848x848px:
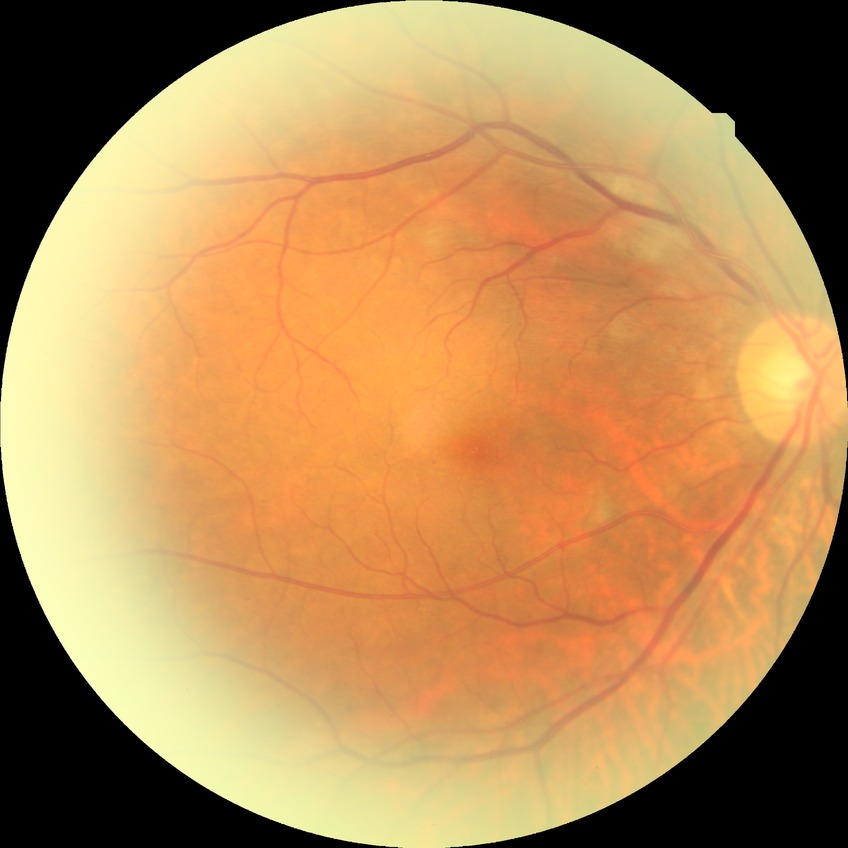

davis_grade: pre-proliferative diabetic retinopathy (PPDR)